Wide-field fundus photograph of an infant
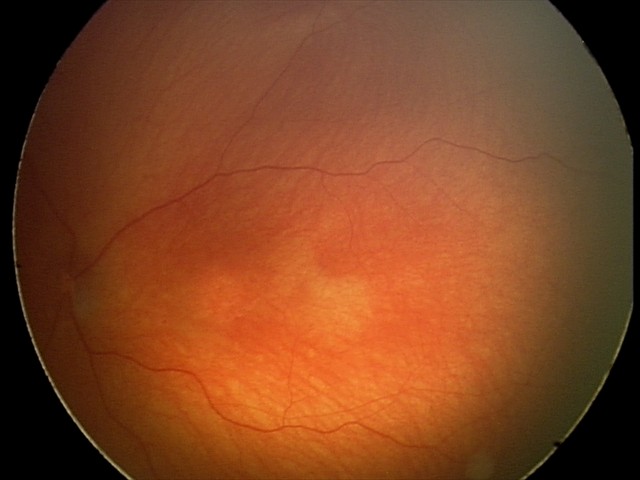 Q: What is the diagnosis from this examination?
A: optic nerve hypoplasia